Phoenix ICON wide-field infant fundus image
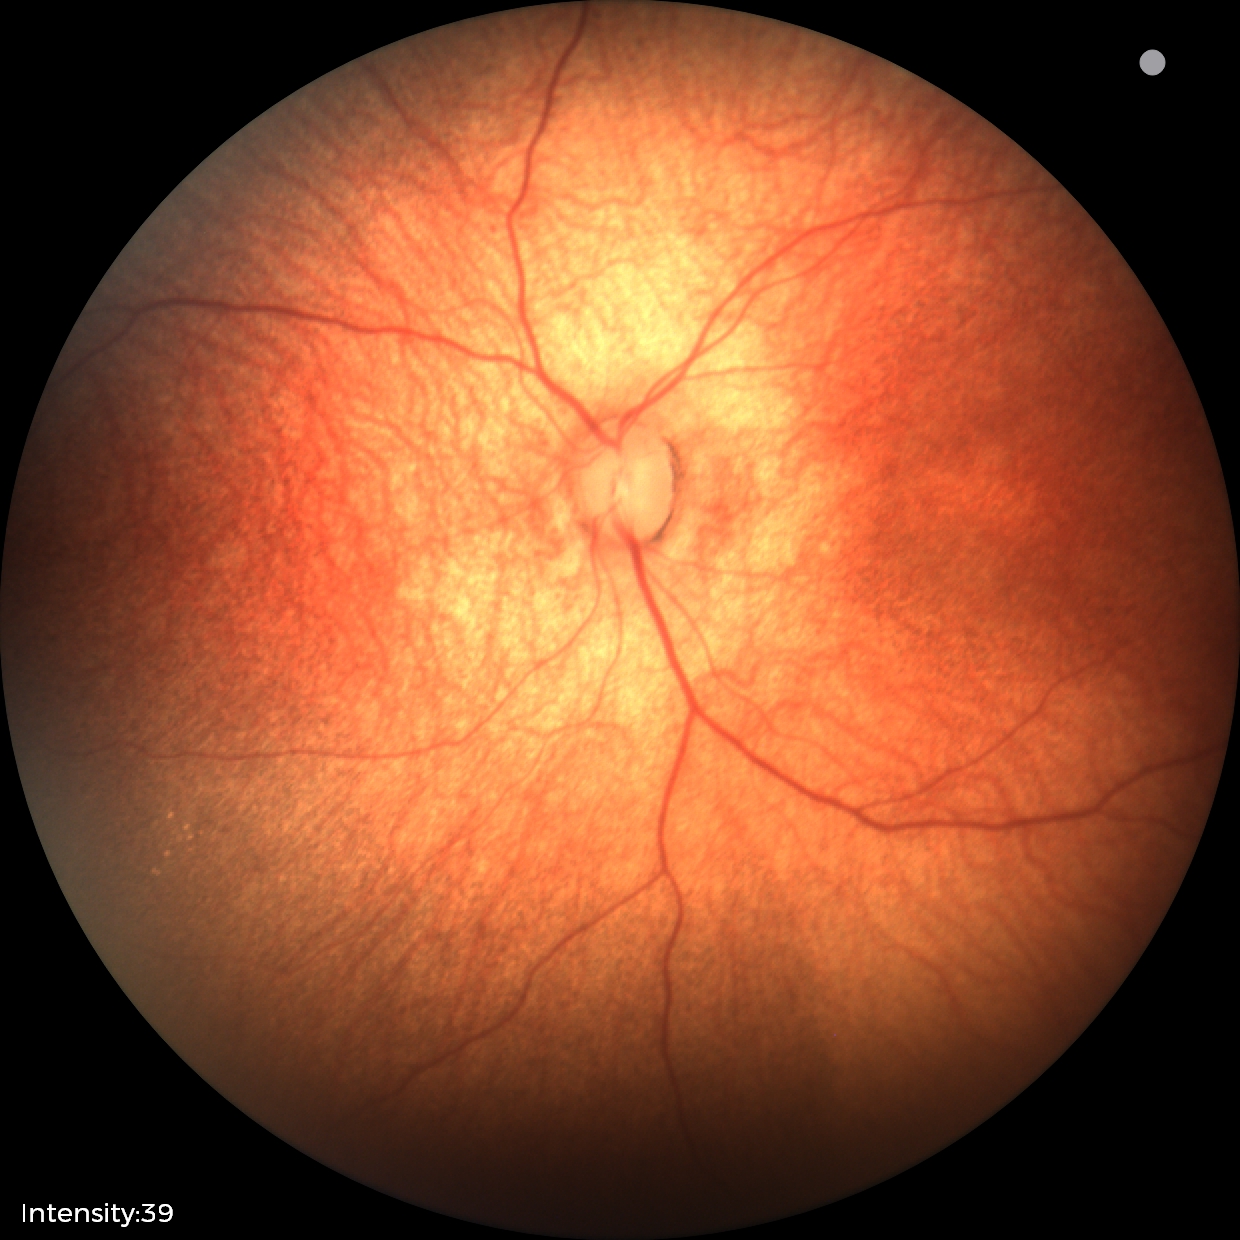

Impression: no abnormal retinal findings.